Graded on the modified Davis scale:
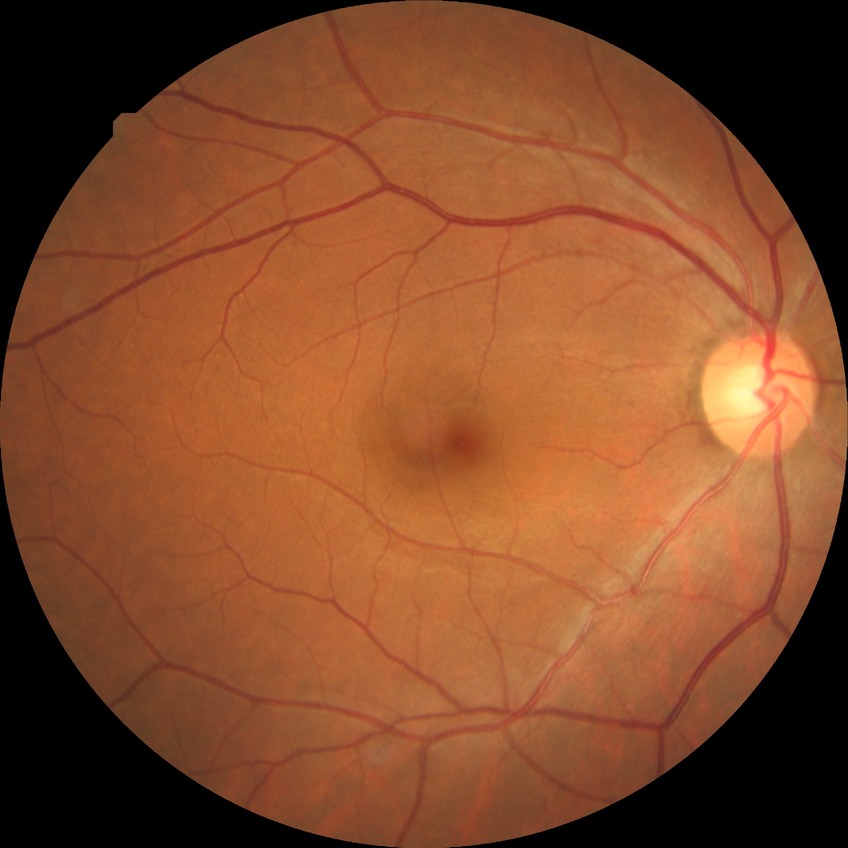
  davis_grade: no diabetic retinopathy (NDR)